Pediatric retinal photograph (wide-field) · 100° field of view (Phoenix ICON):
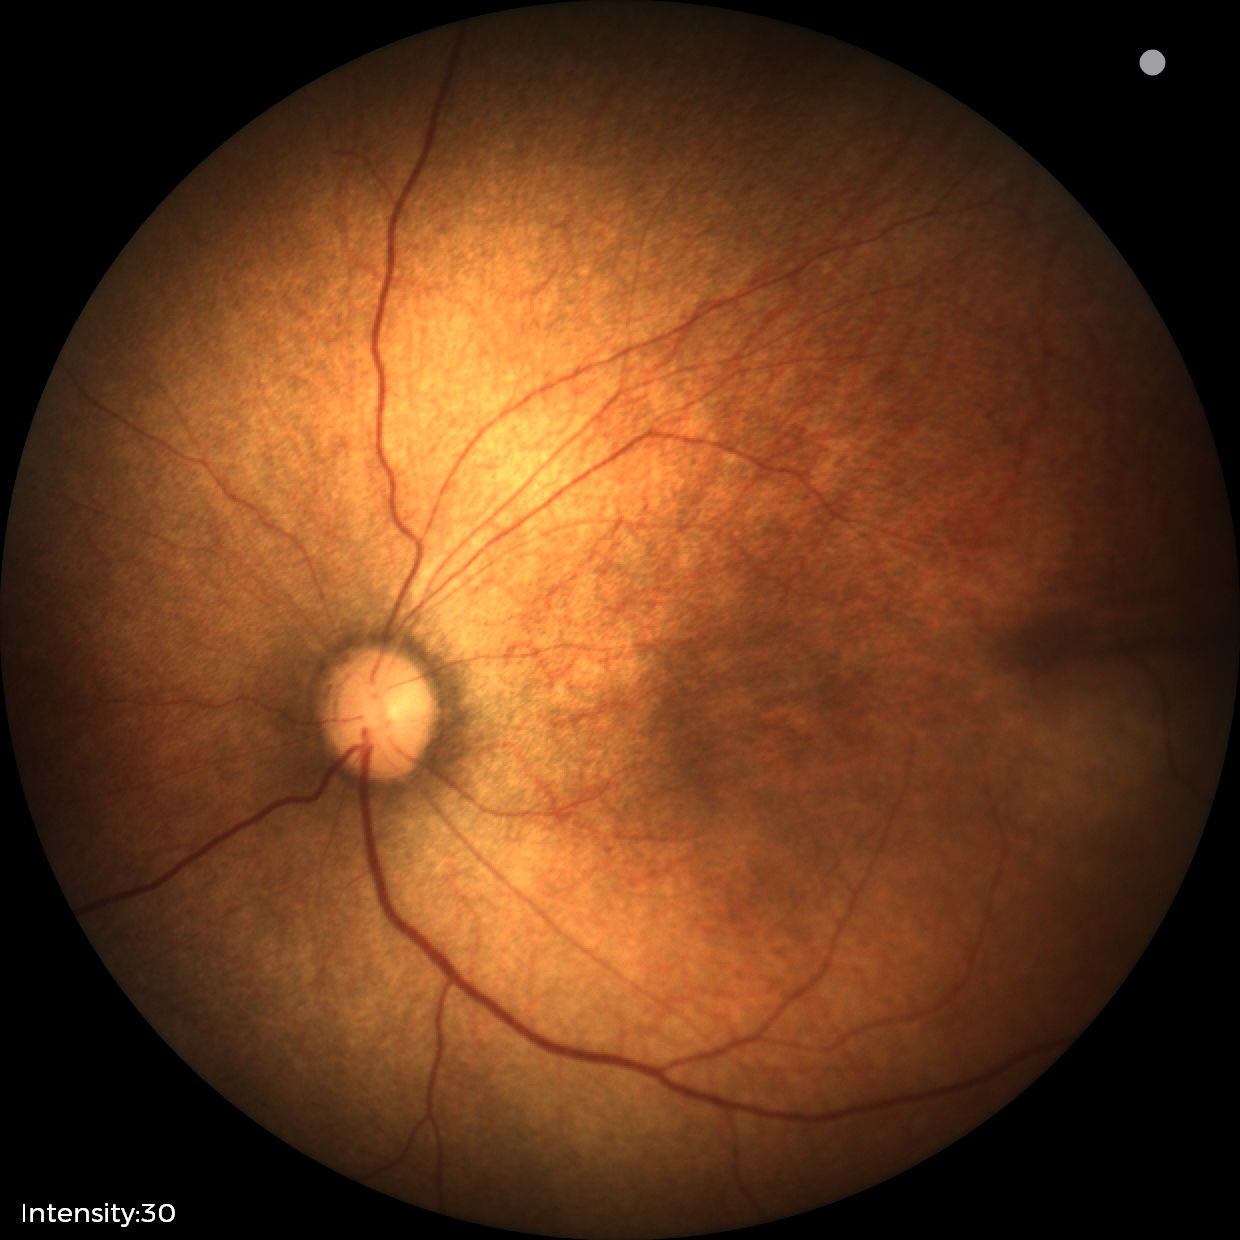

Physiological retinal appearance for postconceptual age.